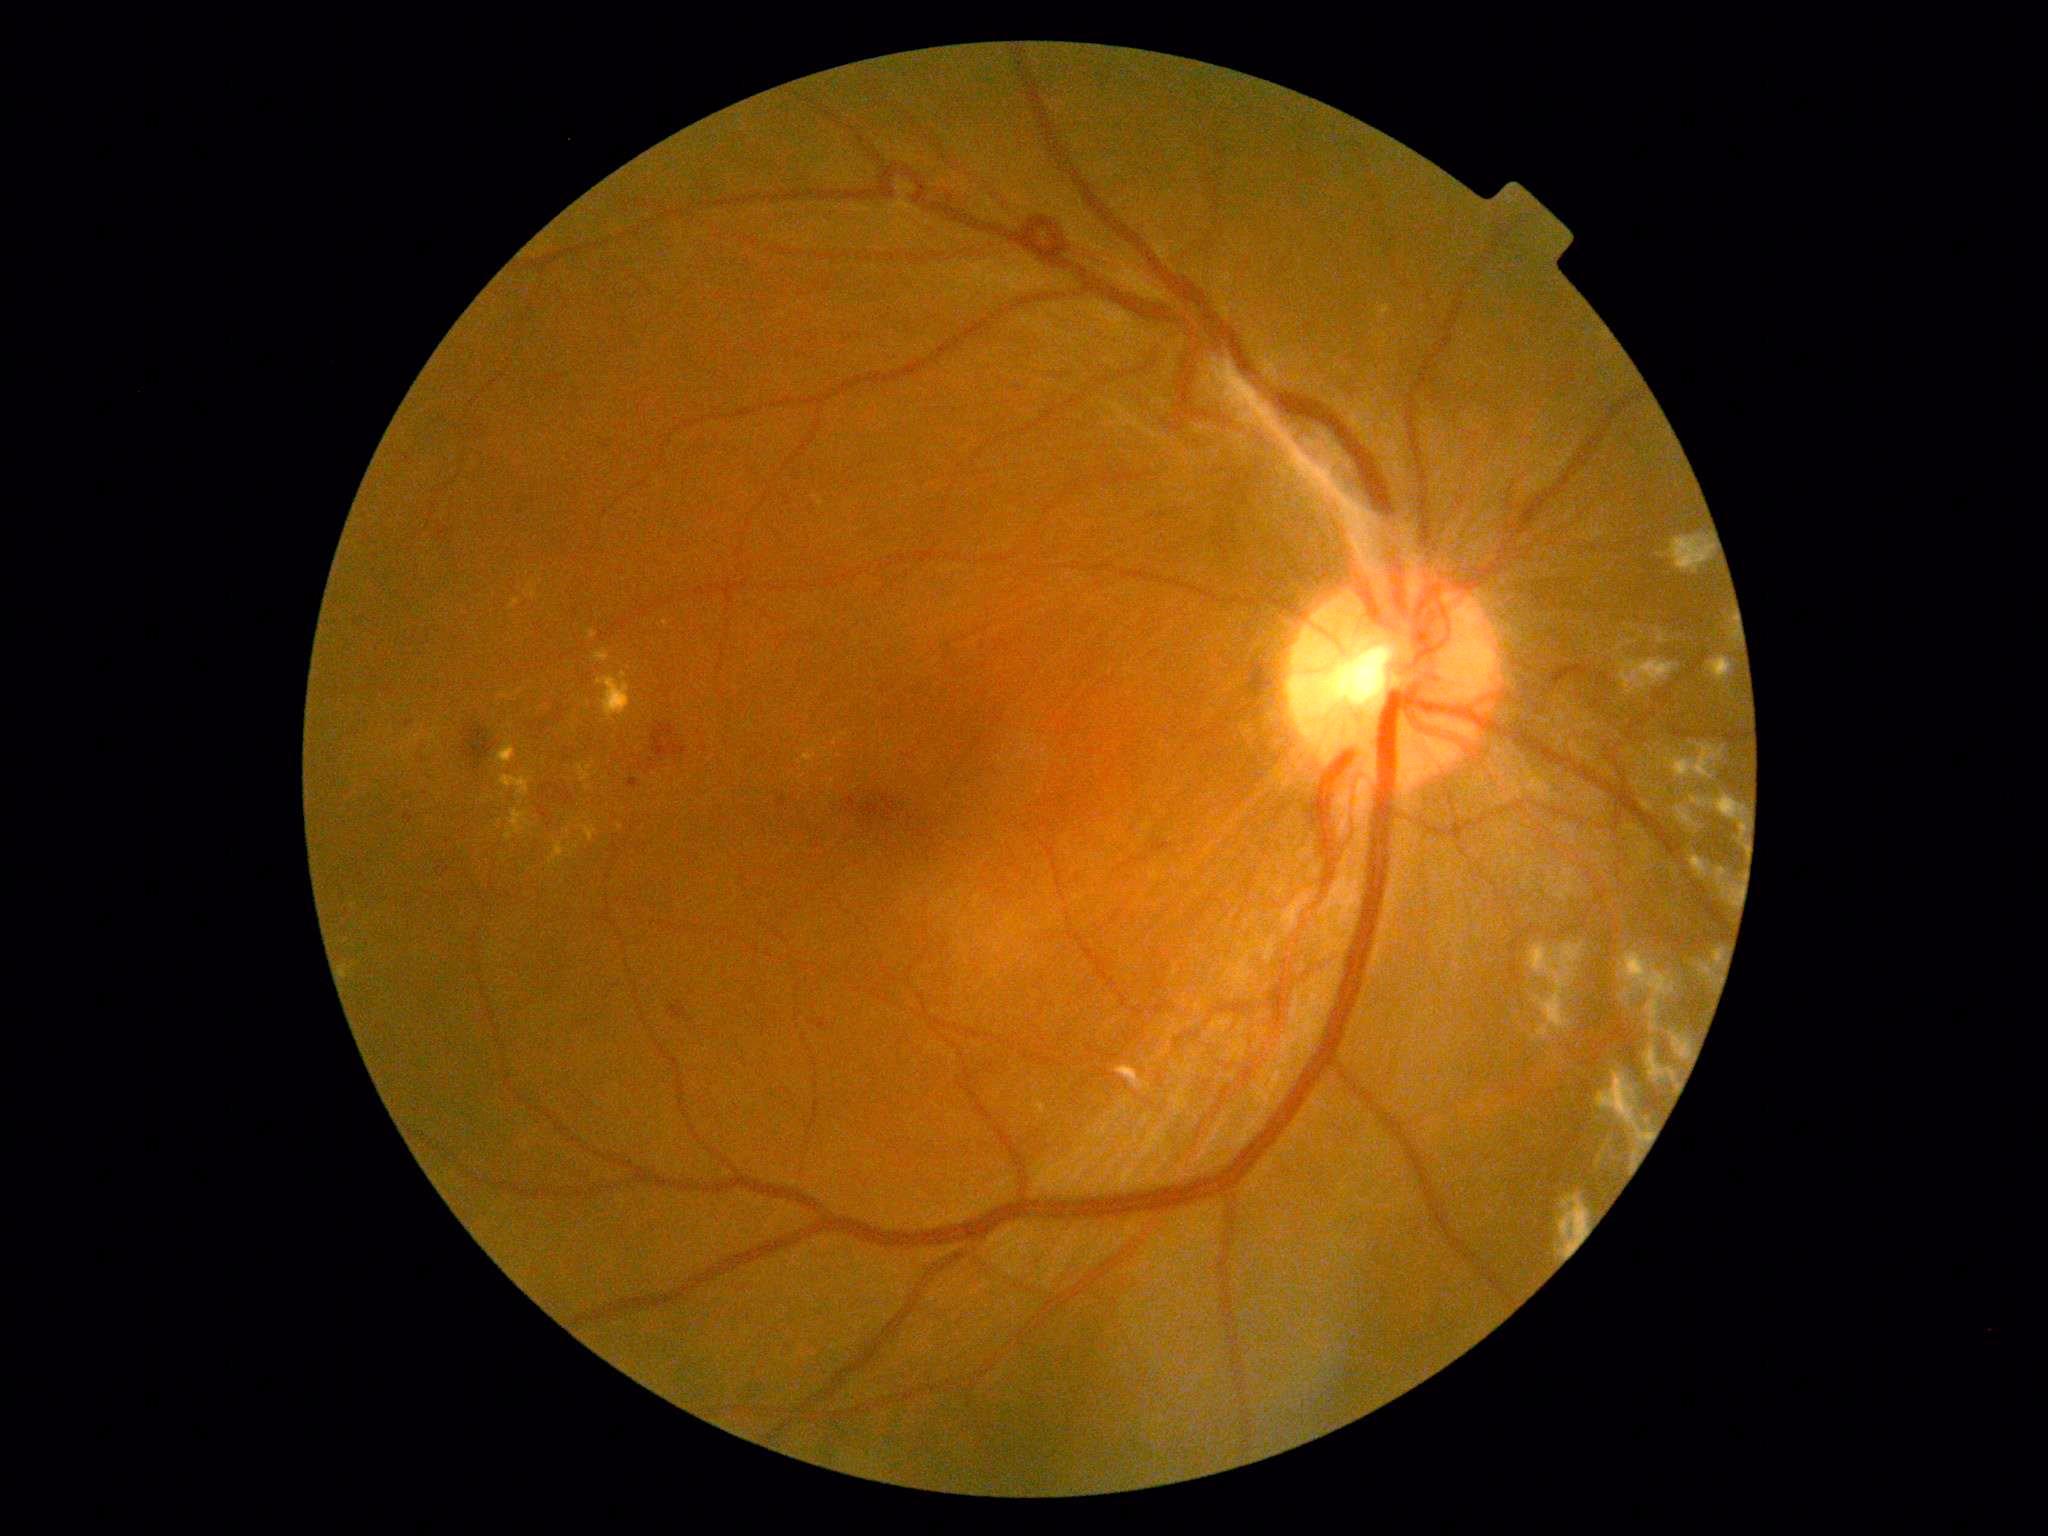
DR stage is grade 4 — neovascularization and/or vitreous/pre-retinal hemorrhage. The retinopathy is classified as proliferative diabetic retinopathy.